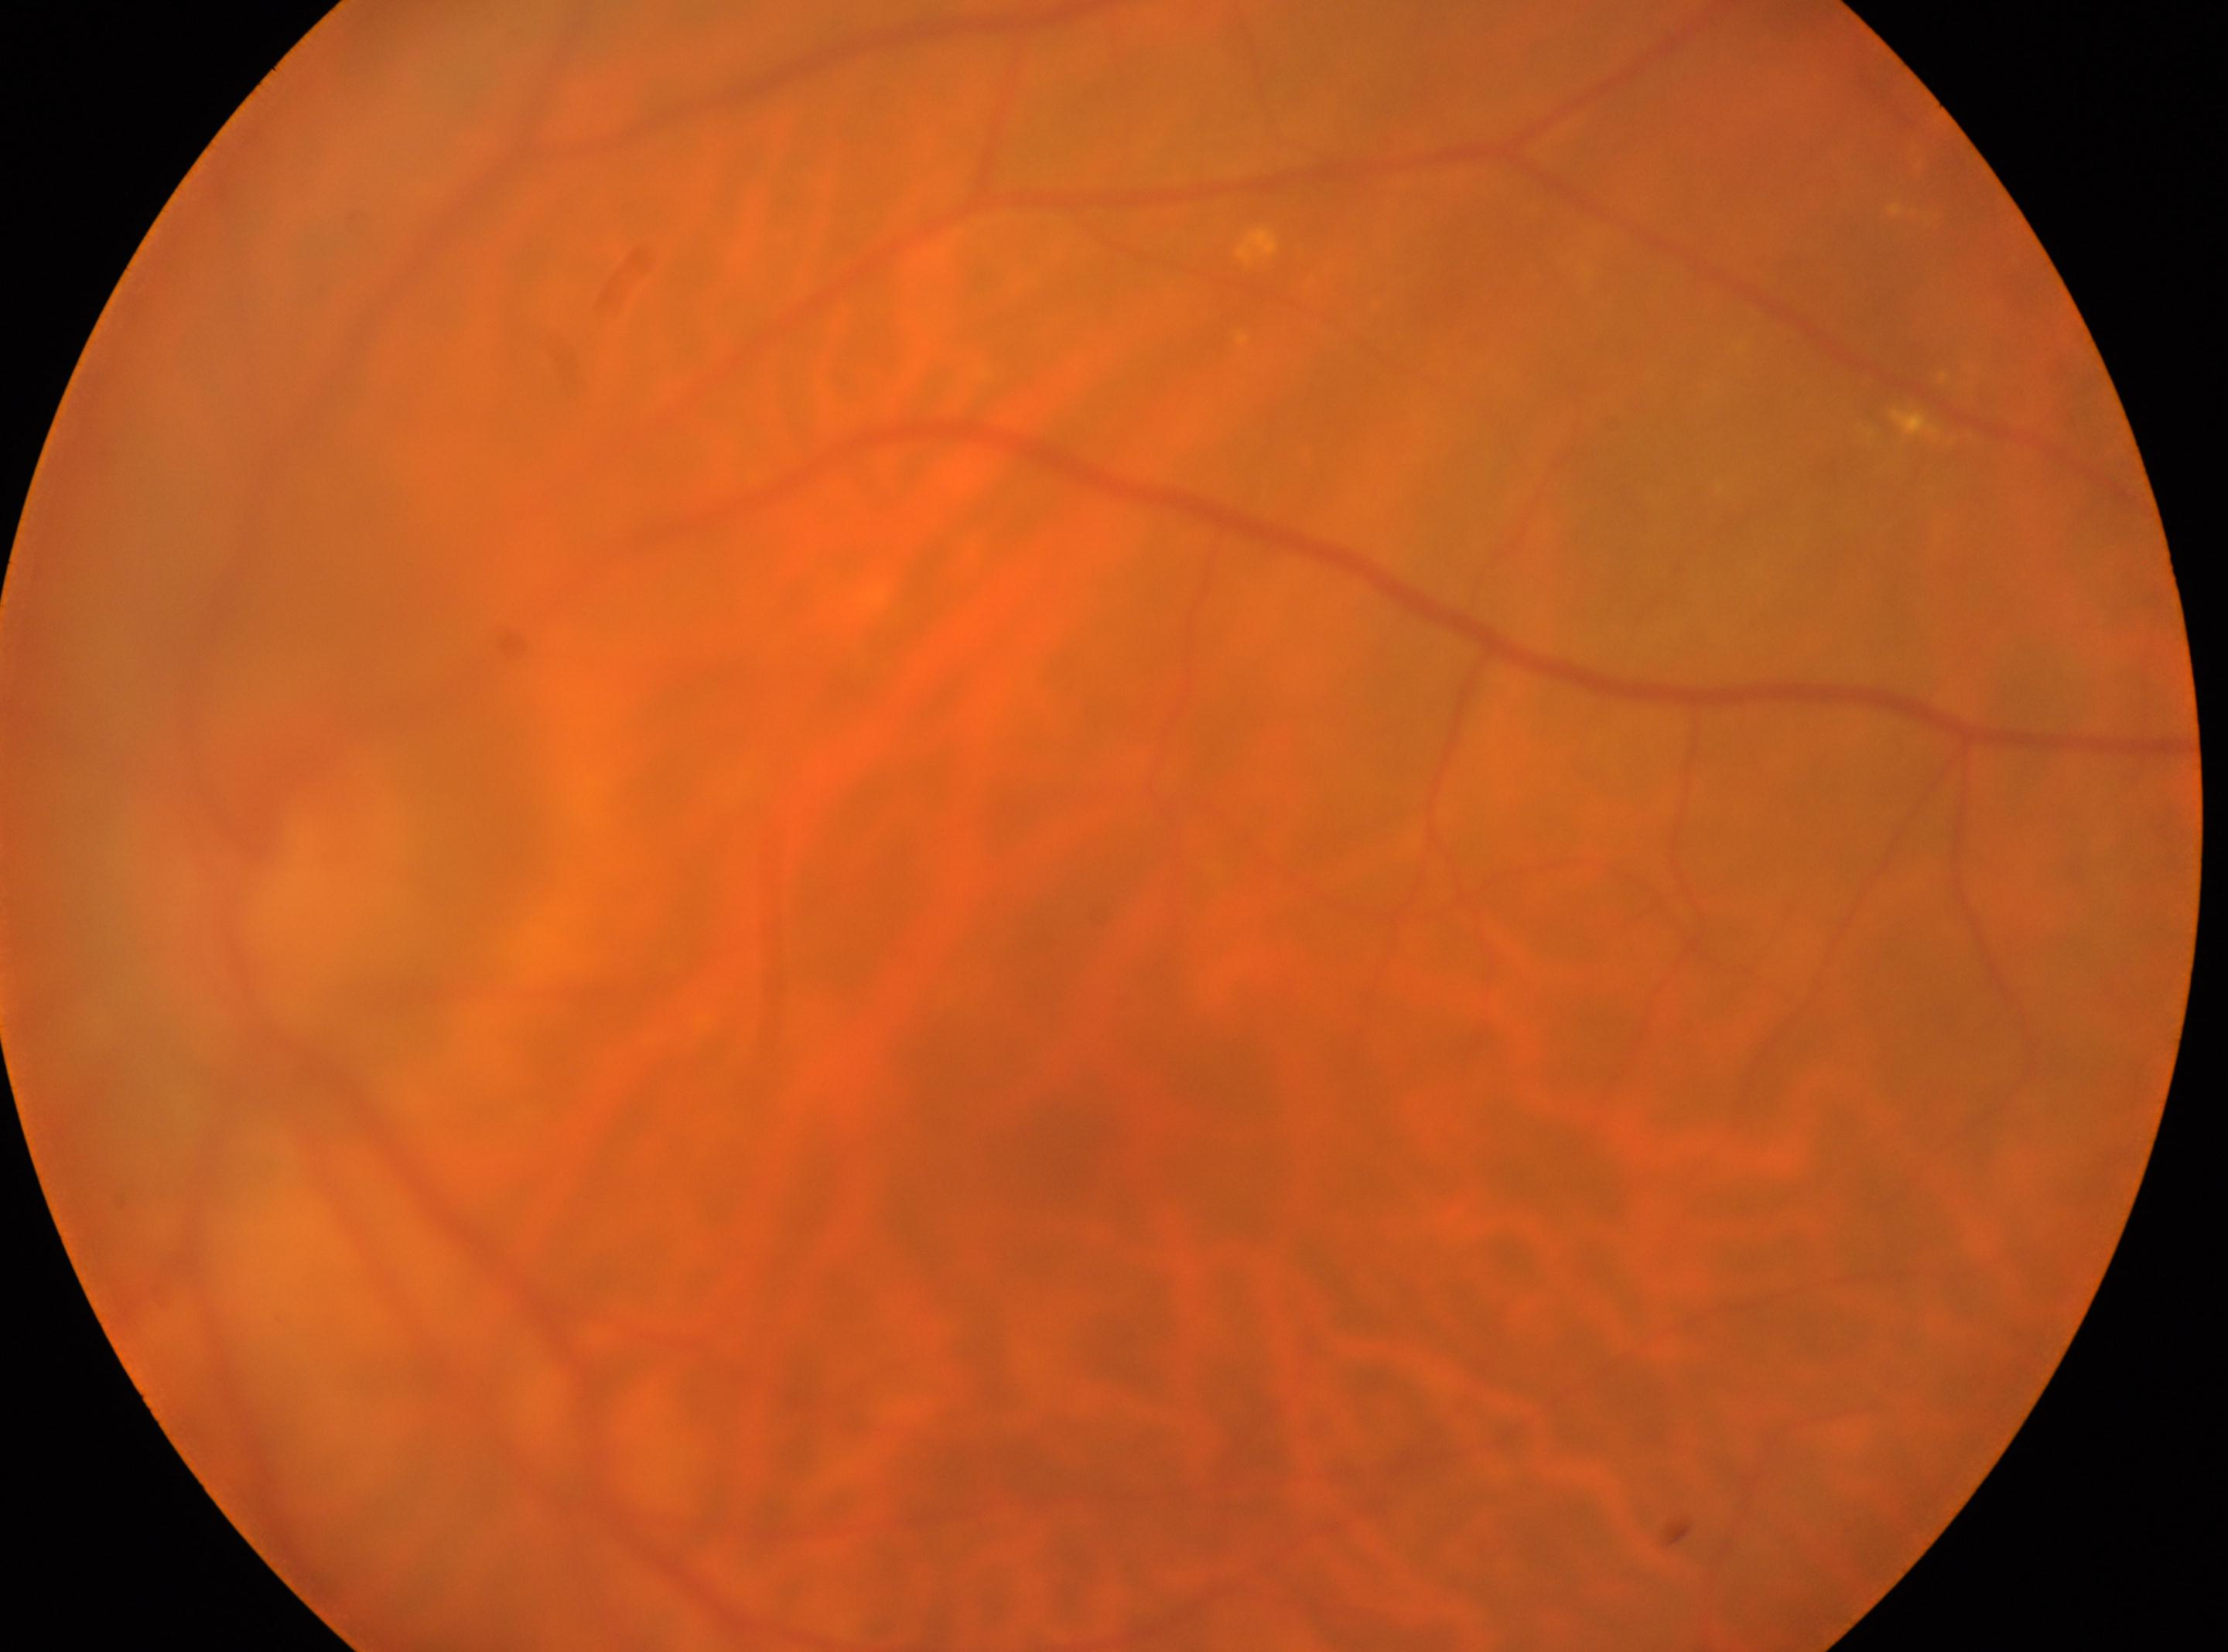 Macula center located at (1075, 1165). Diabetic retinopathy (DR) is 2/4 — more than just microaneurysms but less than severe NPDR. Imaged eye: left eye. Optic disc center: (260, 862).